Acquired with a NIDEK AFC-230 · 848 by 848 pixels · 45° field of view — 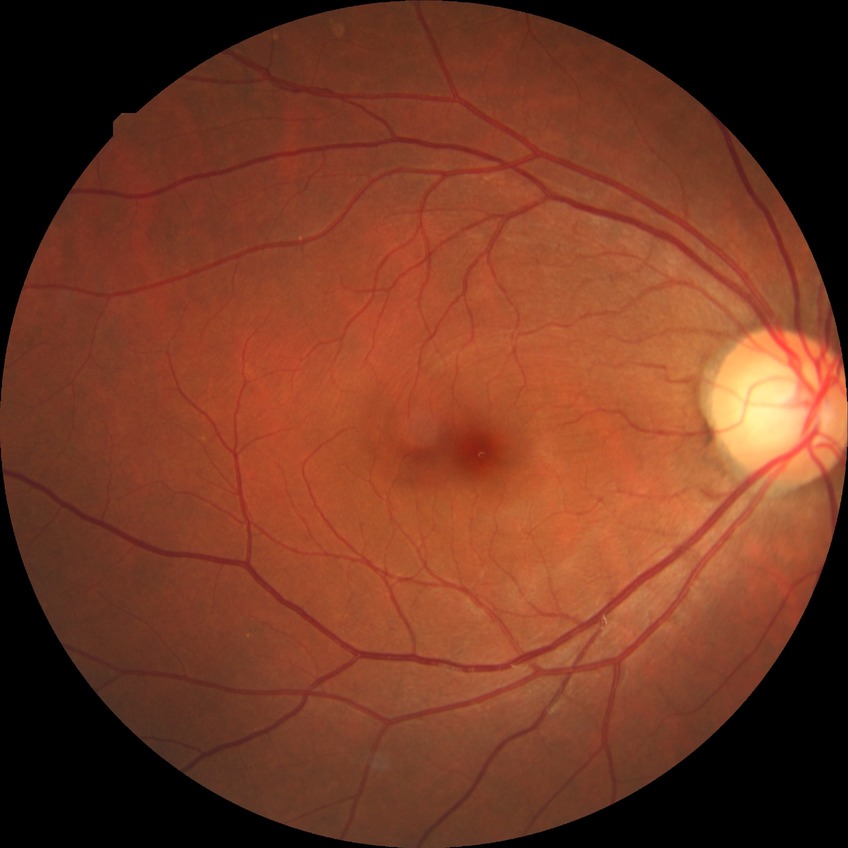 Retinopathy stage is no diabetic retinopathy.